Without pupil dilation, FOV: 45 degrees, retinal fundus photograph: 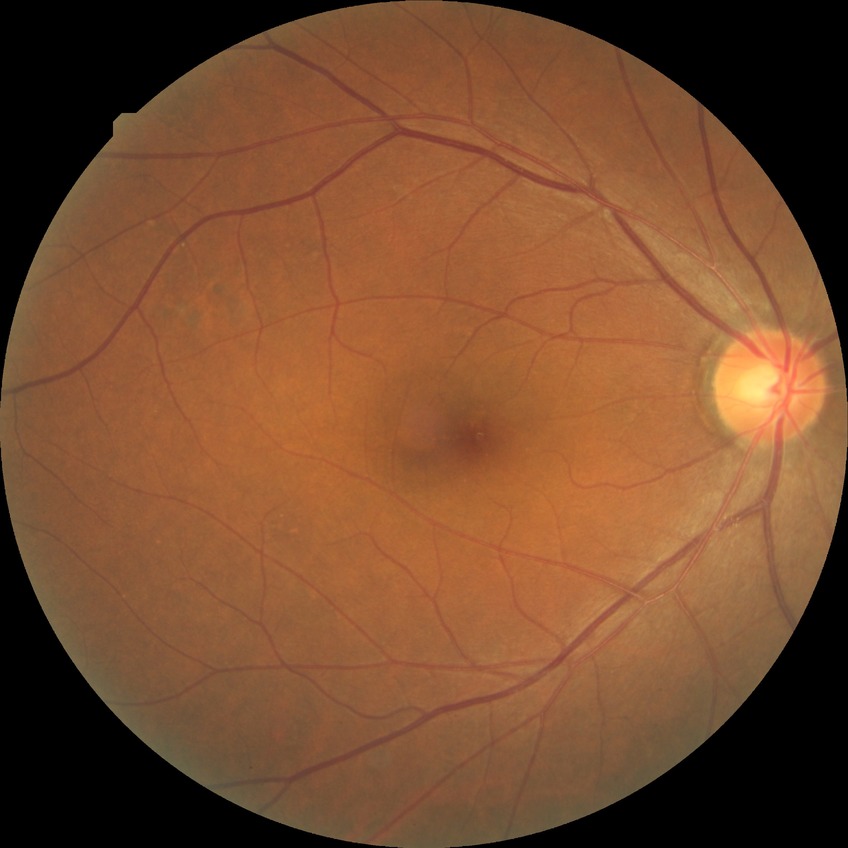 modified Davis grading=no diabetic retinopathy.